Retinal fundus photograph; 848x848px.
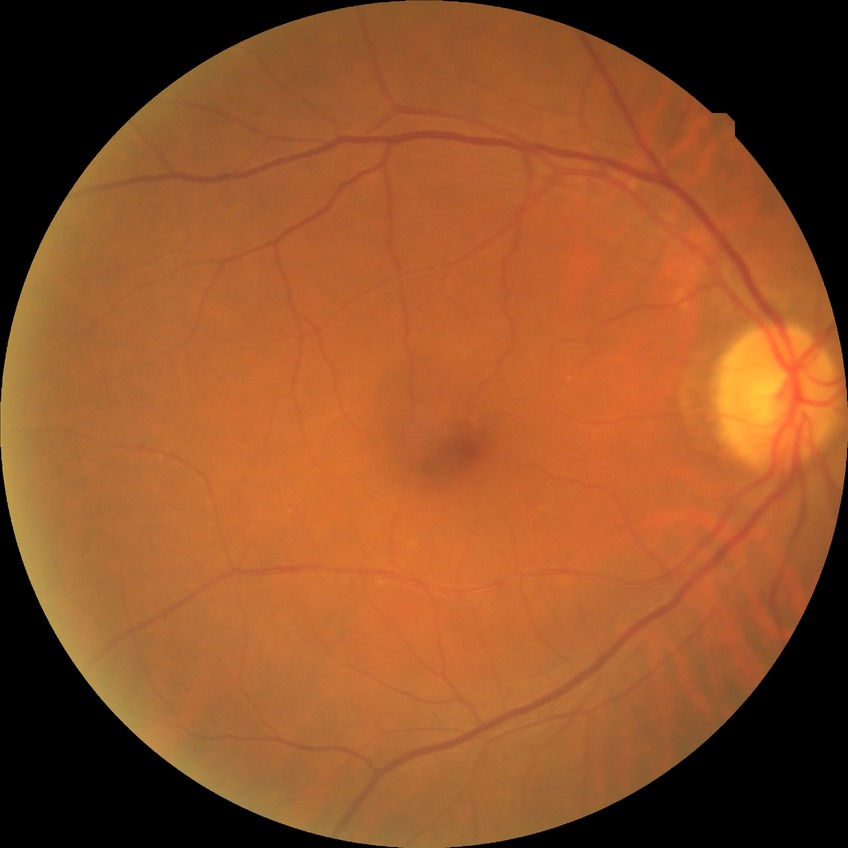 Diabetic retinopathy (DR) is no diabetic retinopathy (NDR).